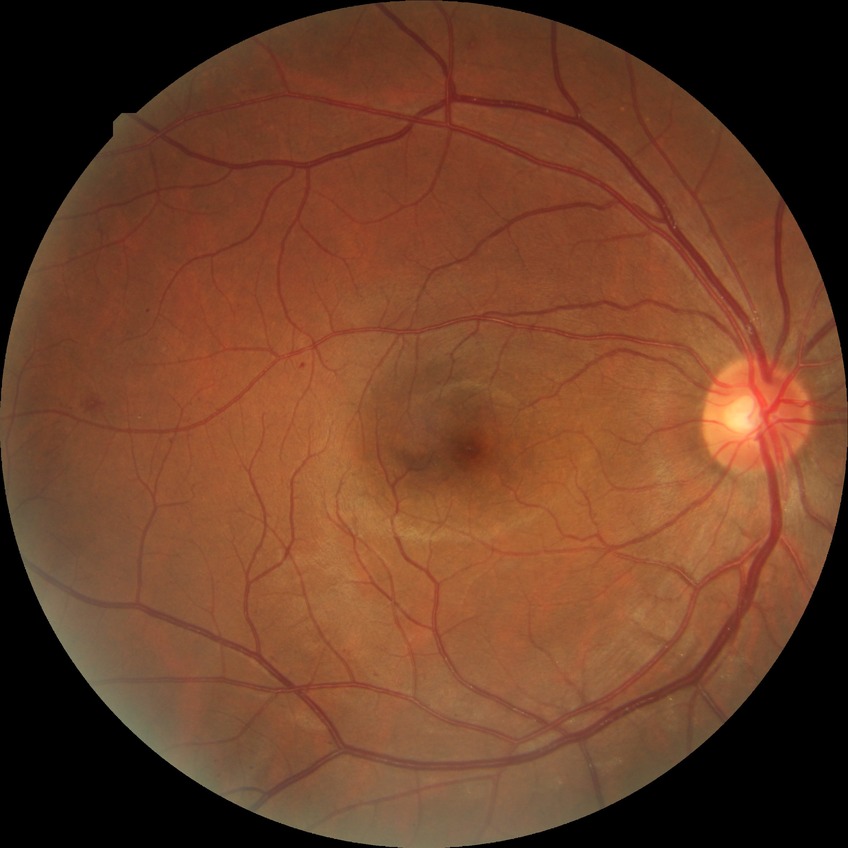 * DR class — non-proliferative diabetic retinopathy
* diabetic retinopathy (DR) — SDR (simple diabetic retinopathy)